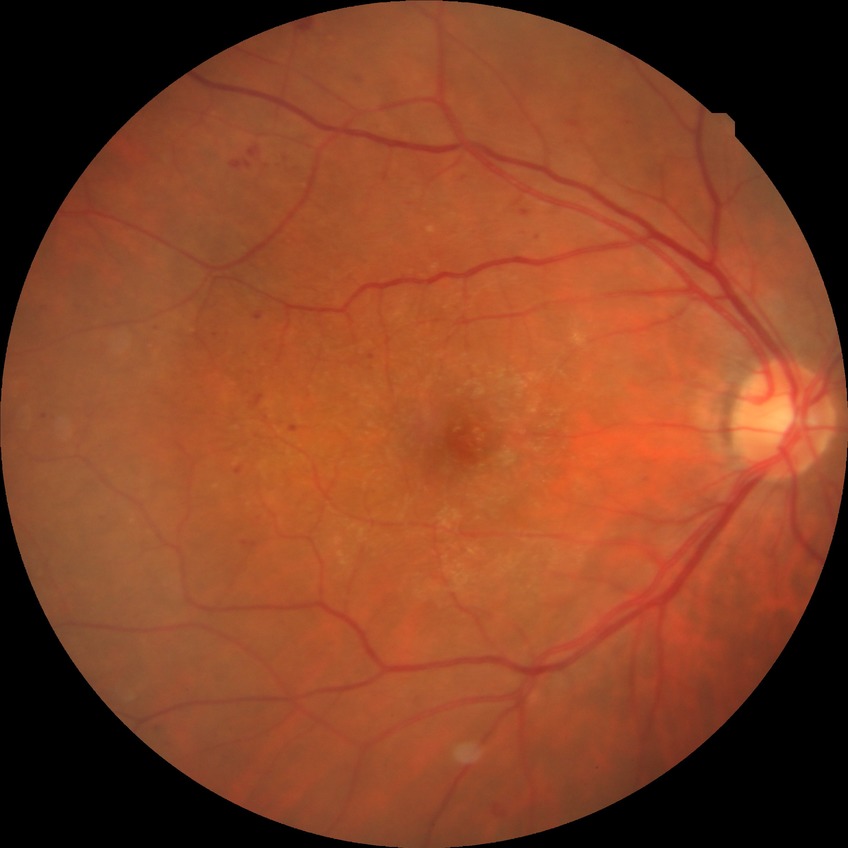 Davis grade: SDR